848x848px; 45° field of view:
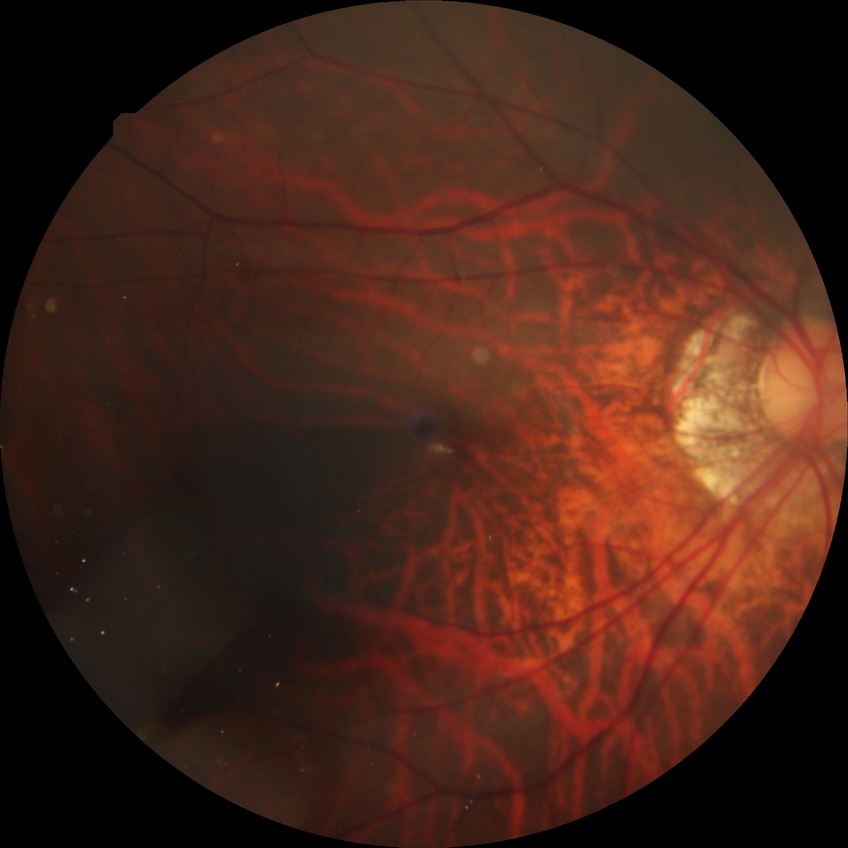

{
  "davis_grade": "no diabetic retinopathy (NDR)"
}